1659x2212px, fundus photo
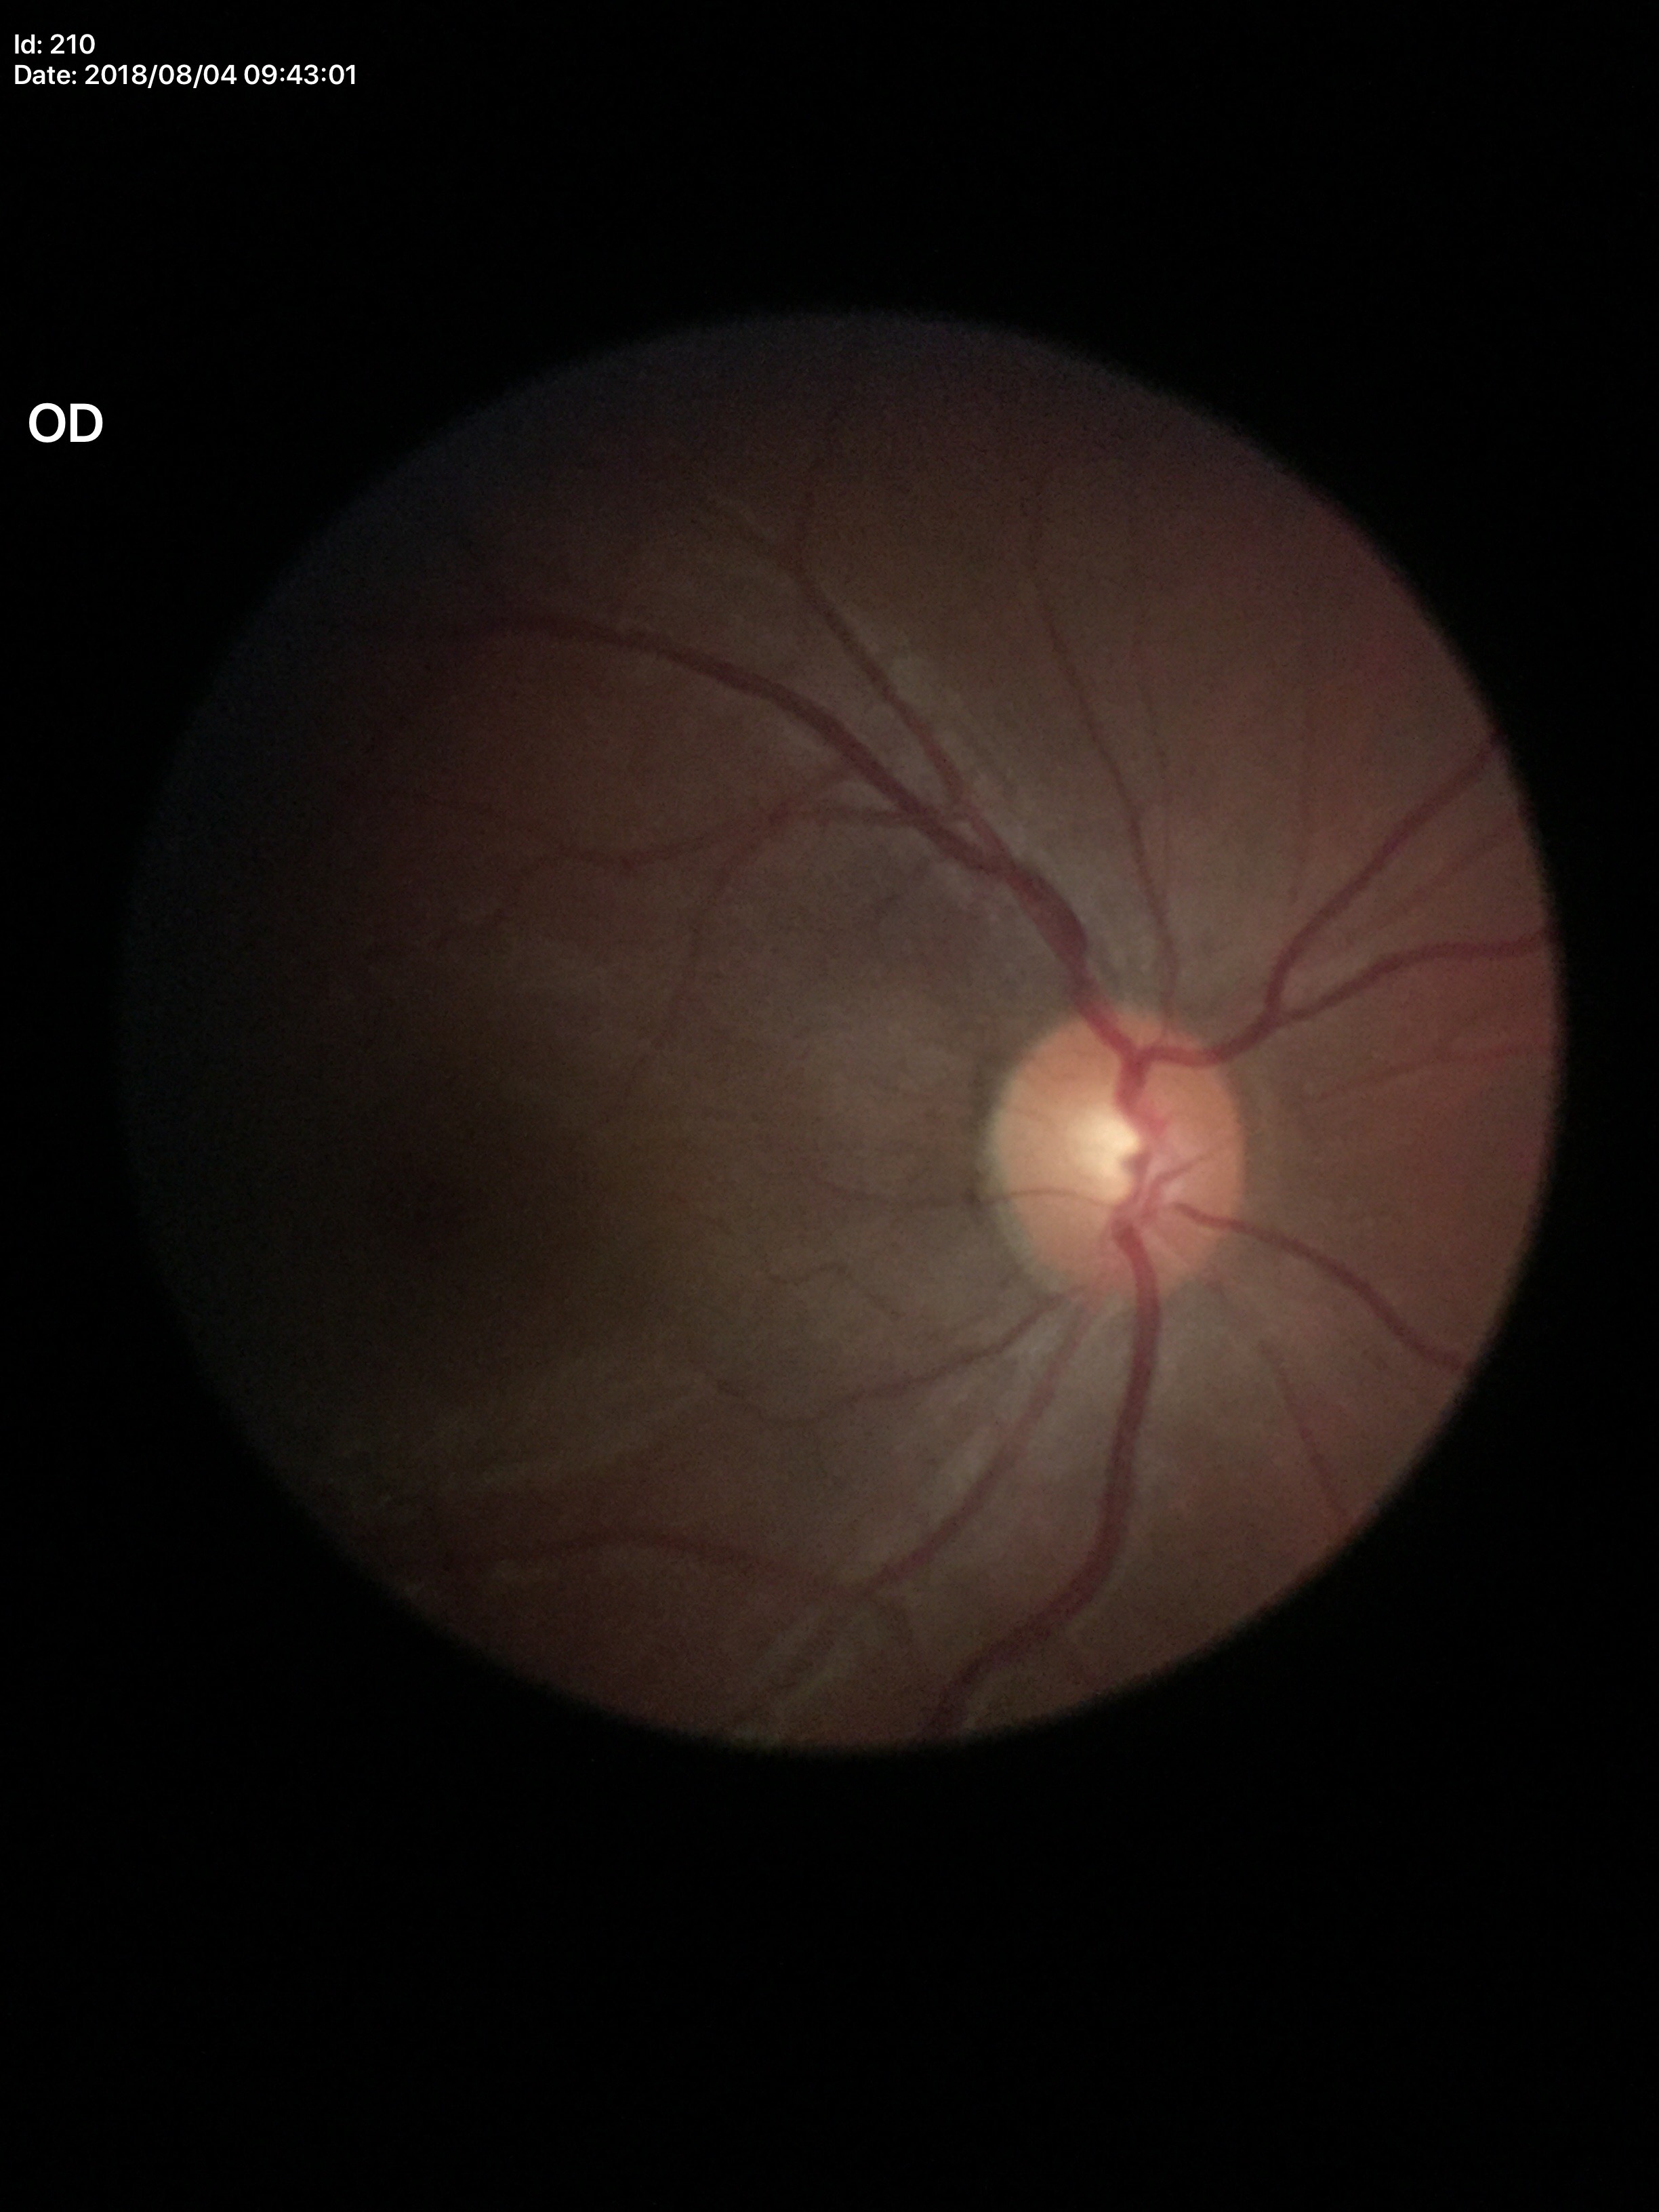

Glaucoma evaluation: not suspect.
Vertical CDR (VCDR) is 0.47.
Horizontal C/D ratio (HCDR): 0.50.